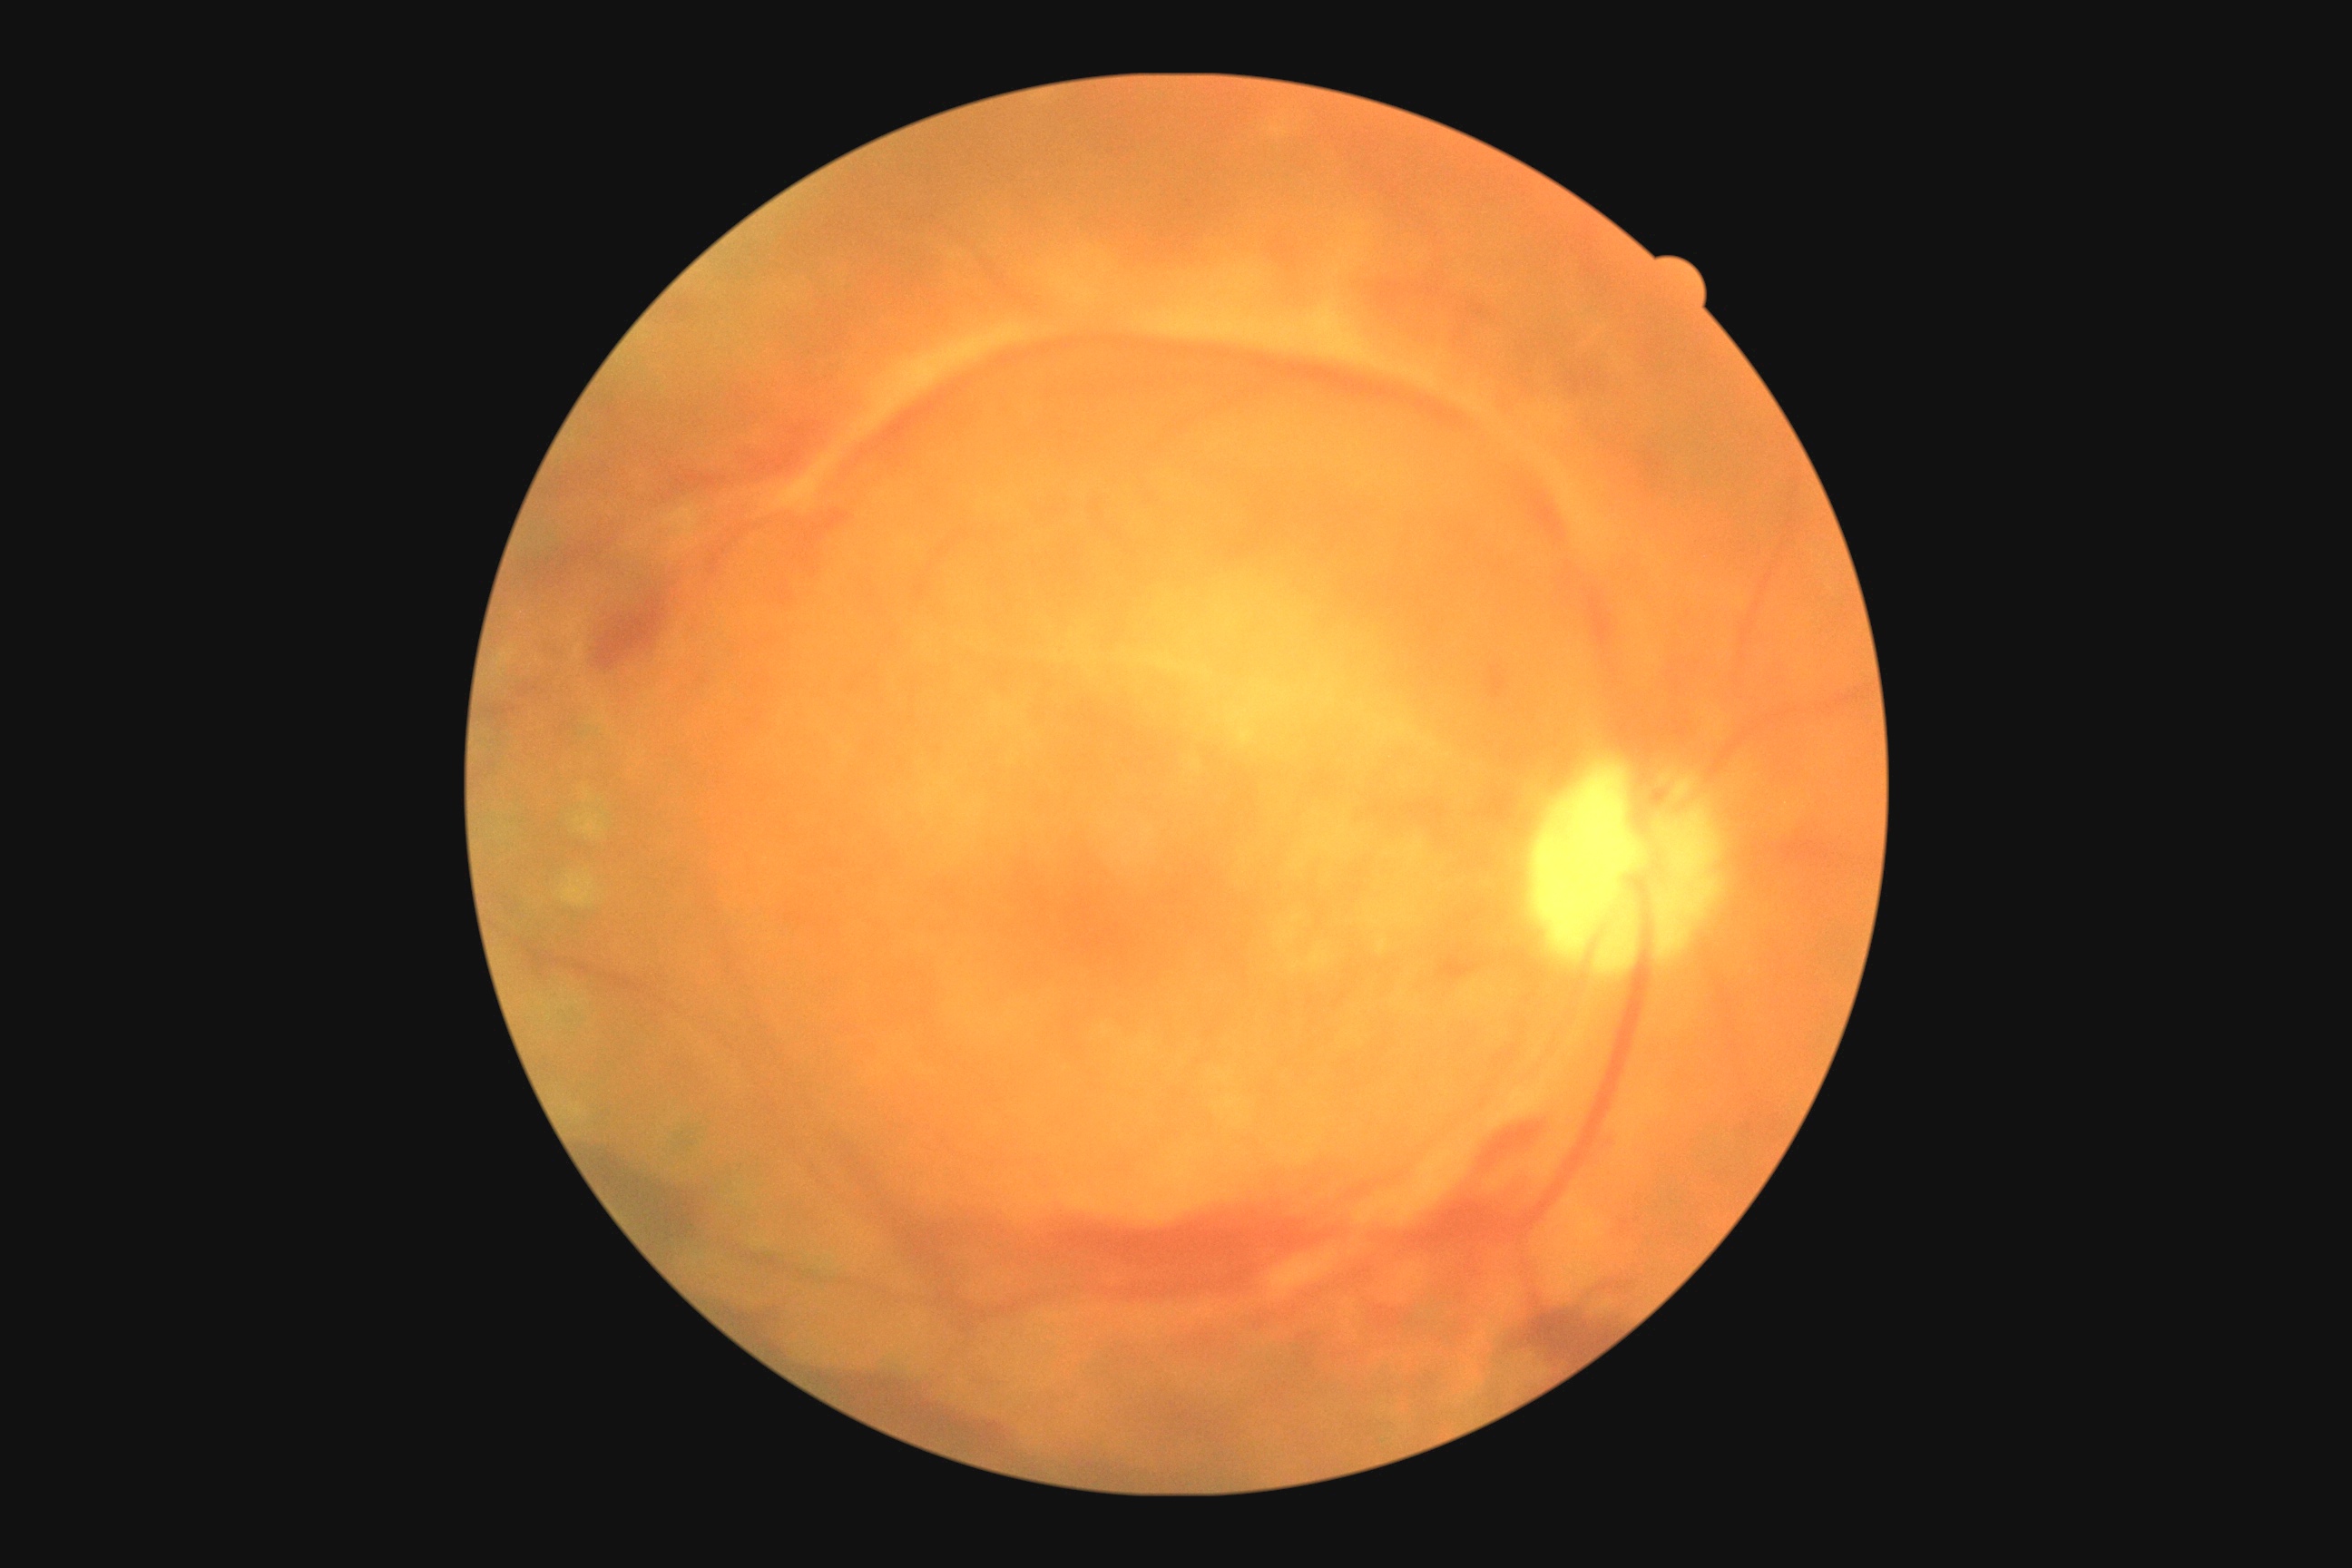

Diabetic retinopathy (DR) is grade 4.
The retinopathy is classified as proliferative diabetic retinopathy.